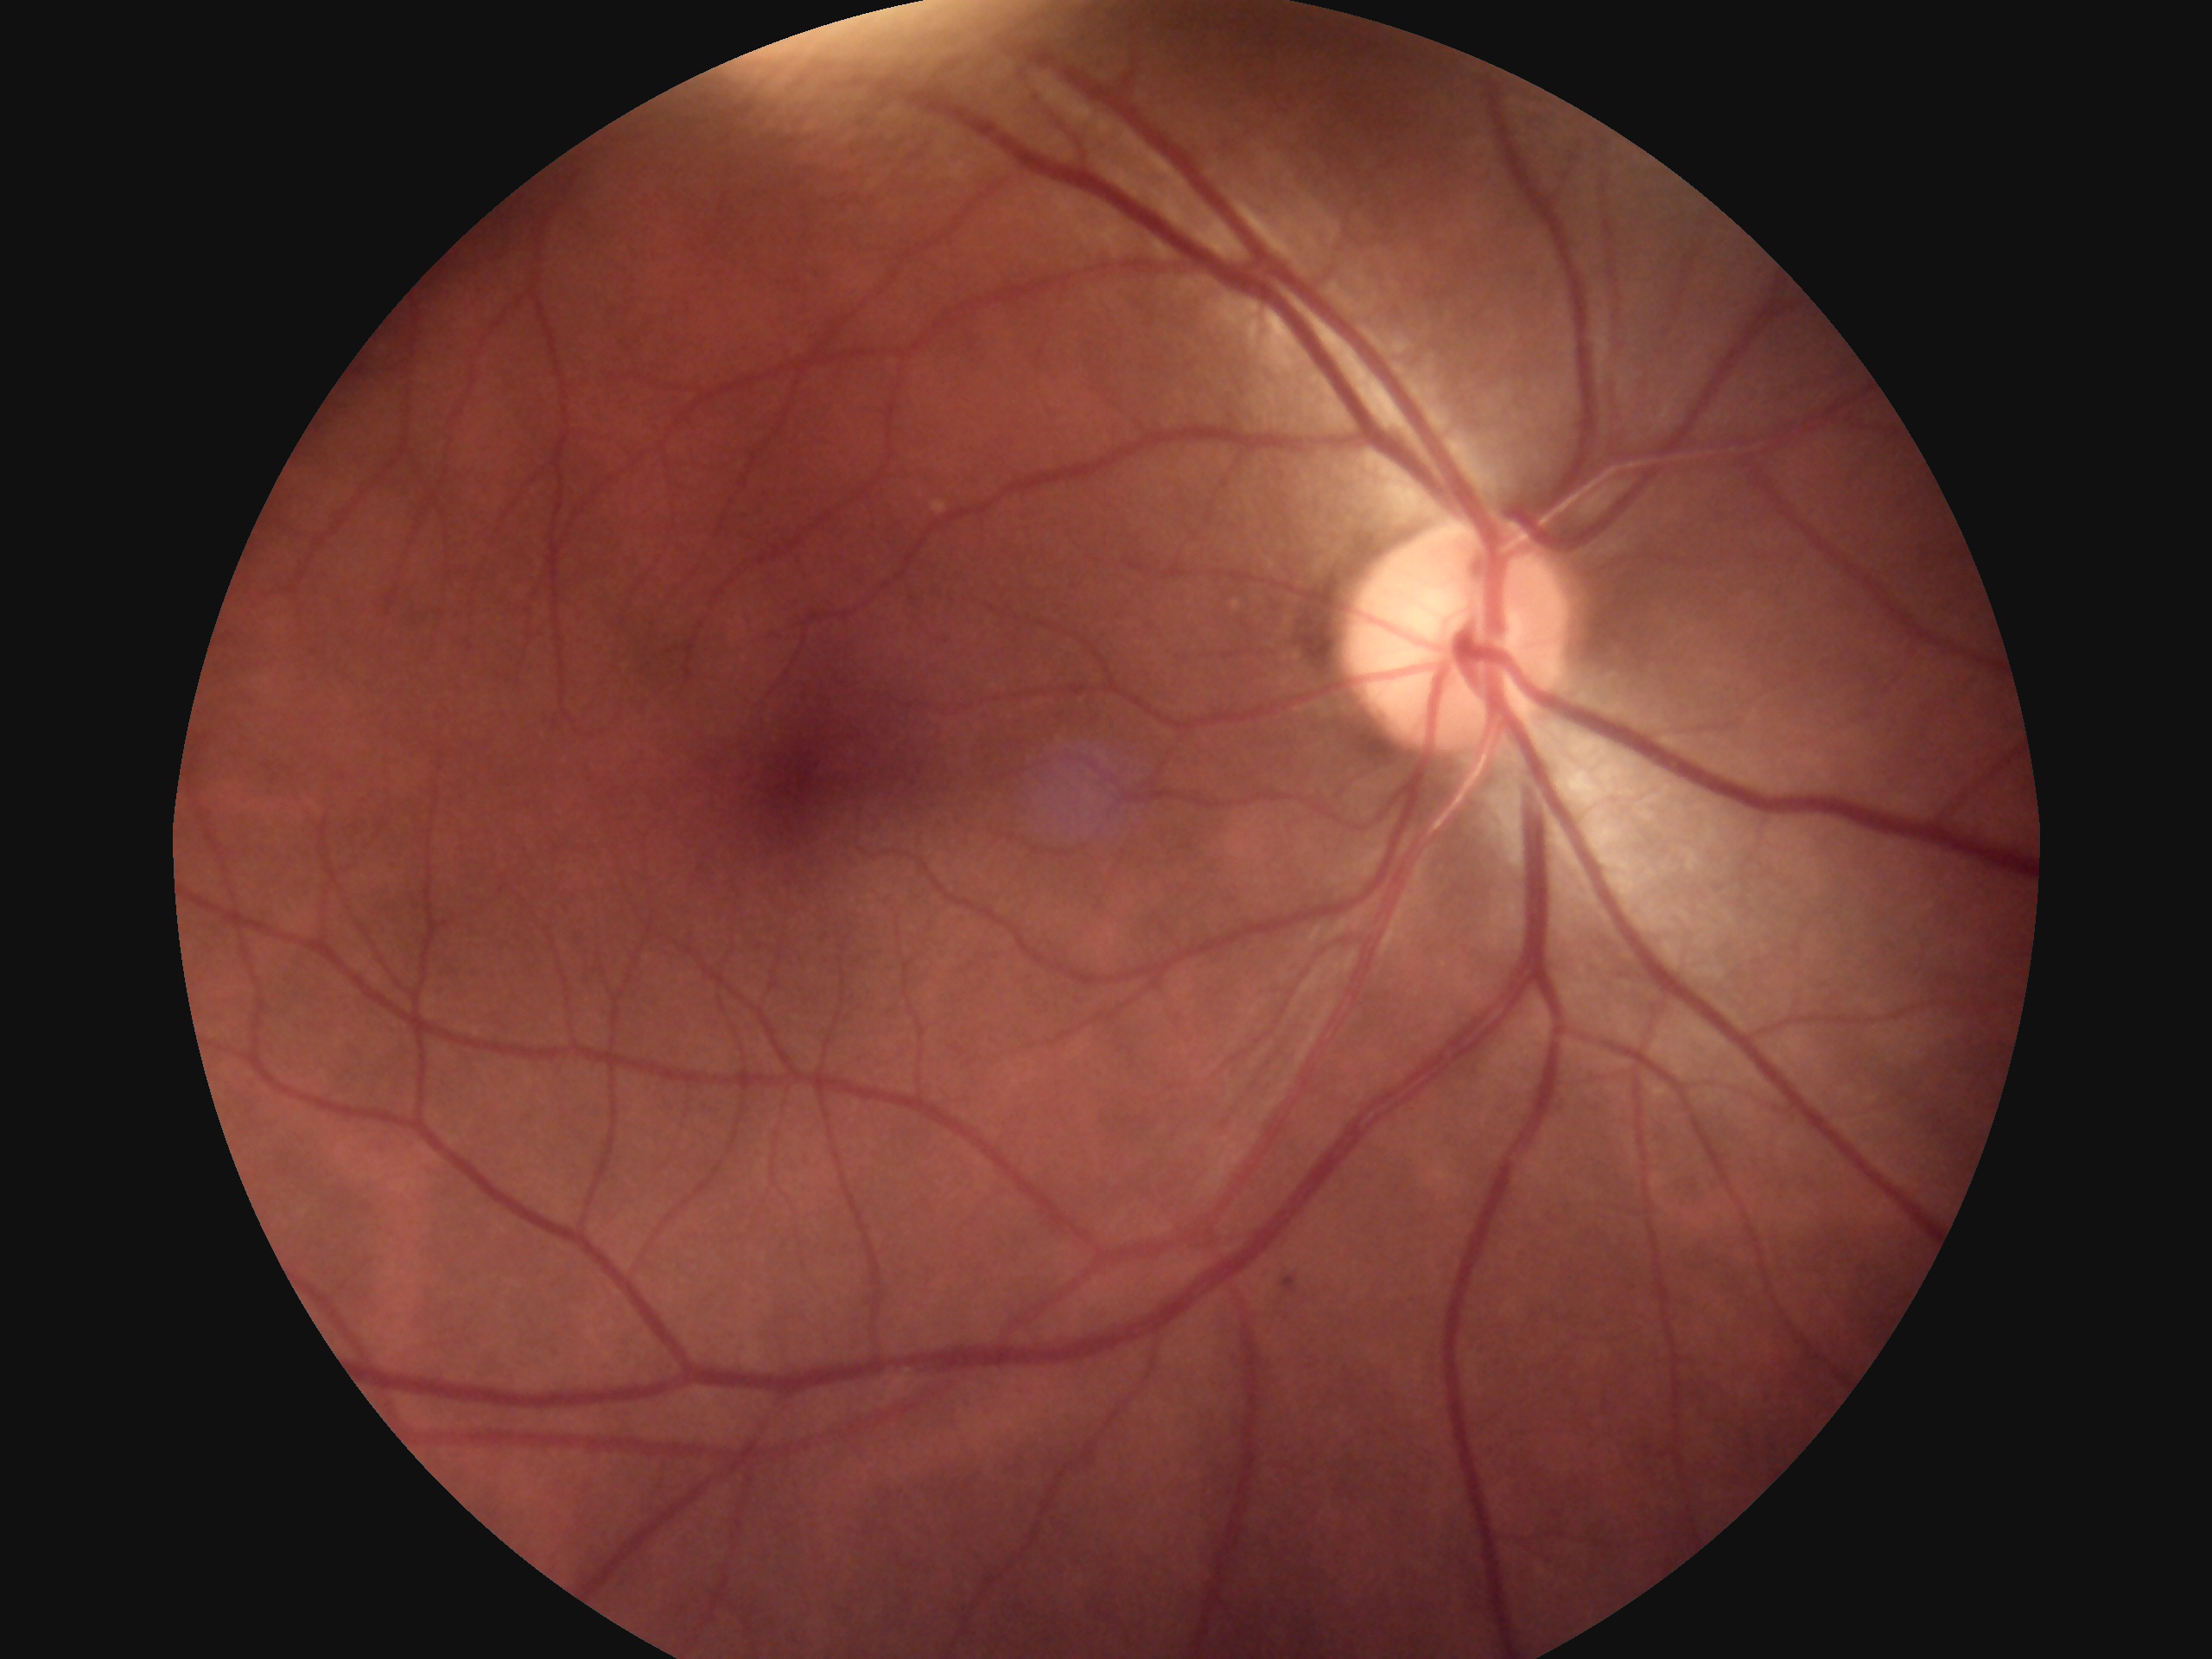
DR impression: no DR findings
retinopathy: 0